2228x1652 · central posterior field · 50° FOV:
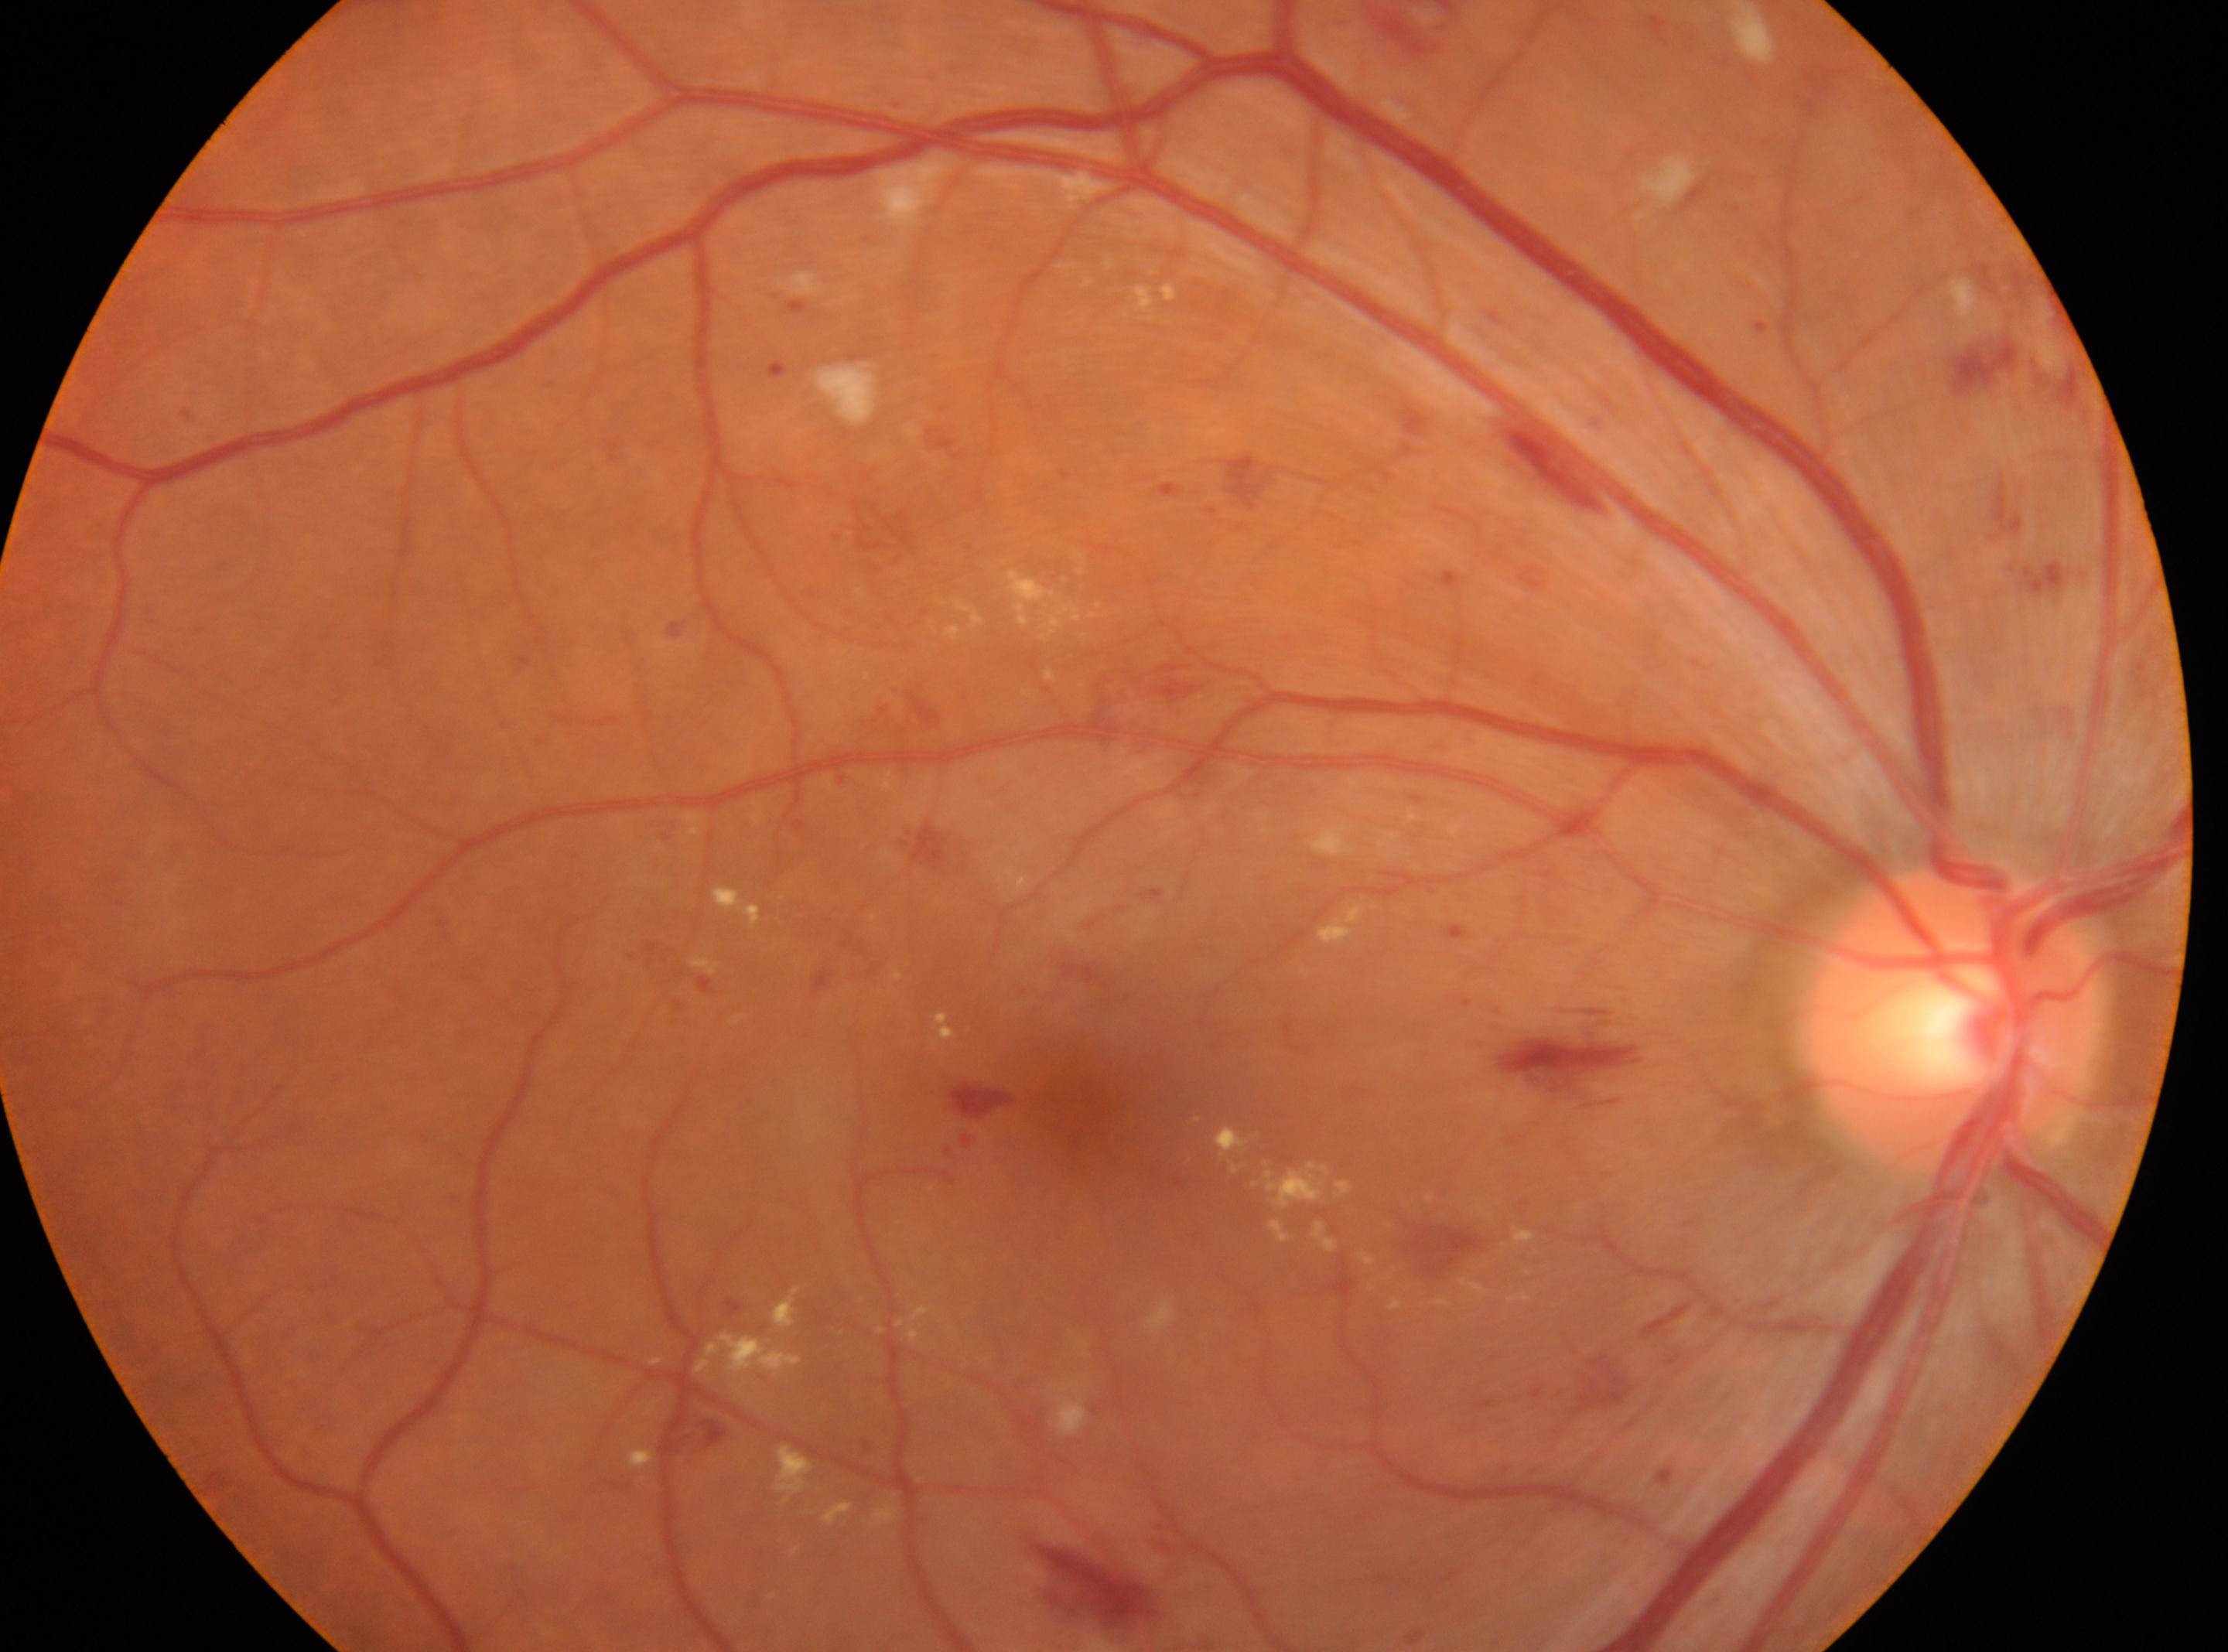

diabetic retinopathy (DR): 2; ONH: x=1952, y=1016; fovea centralis: x=1083, y=1106; DR class: non-proliferative diabetic retinopathy; laterality: oculus dexter.